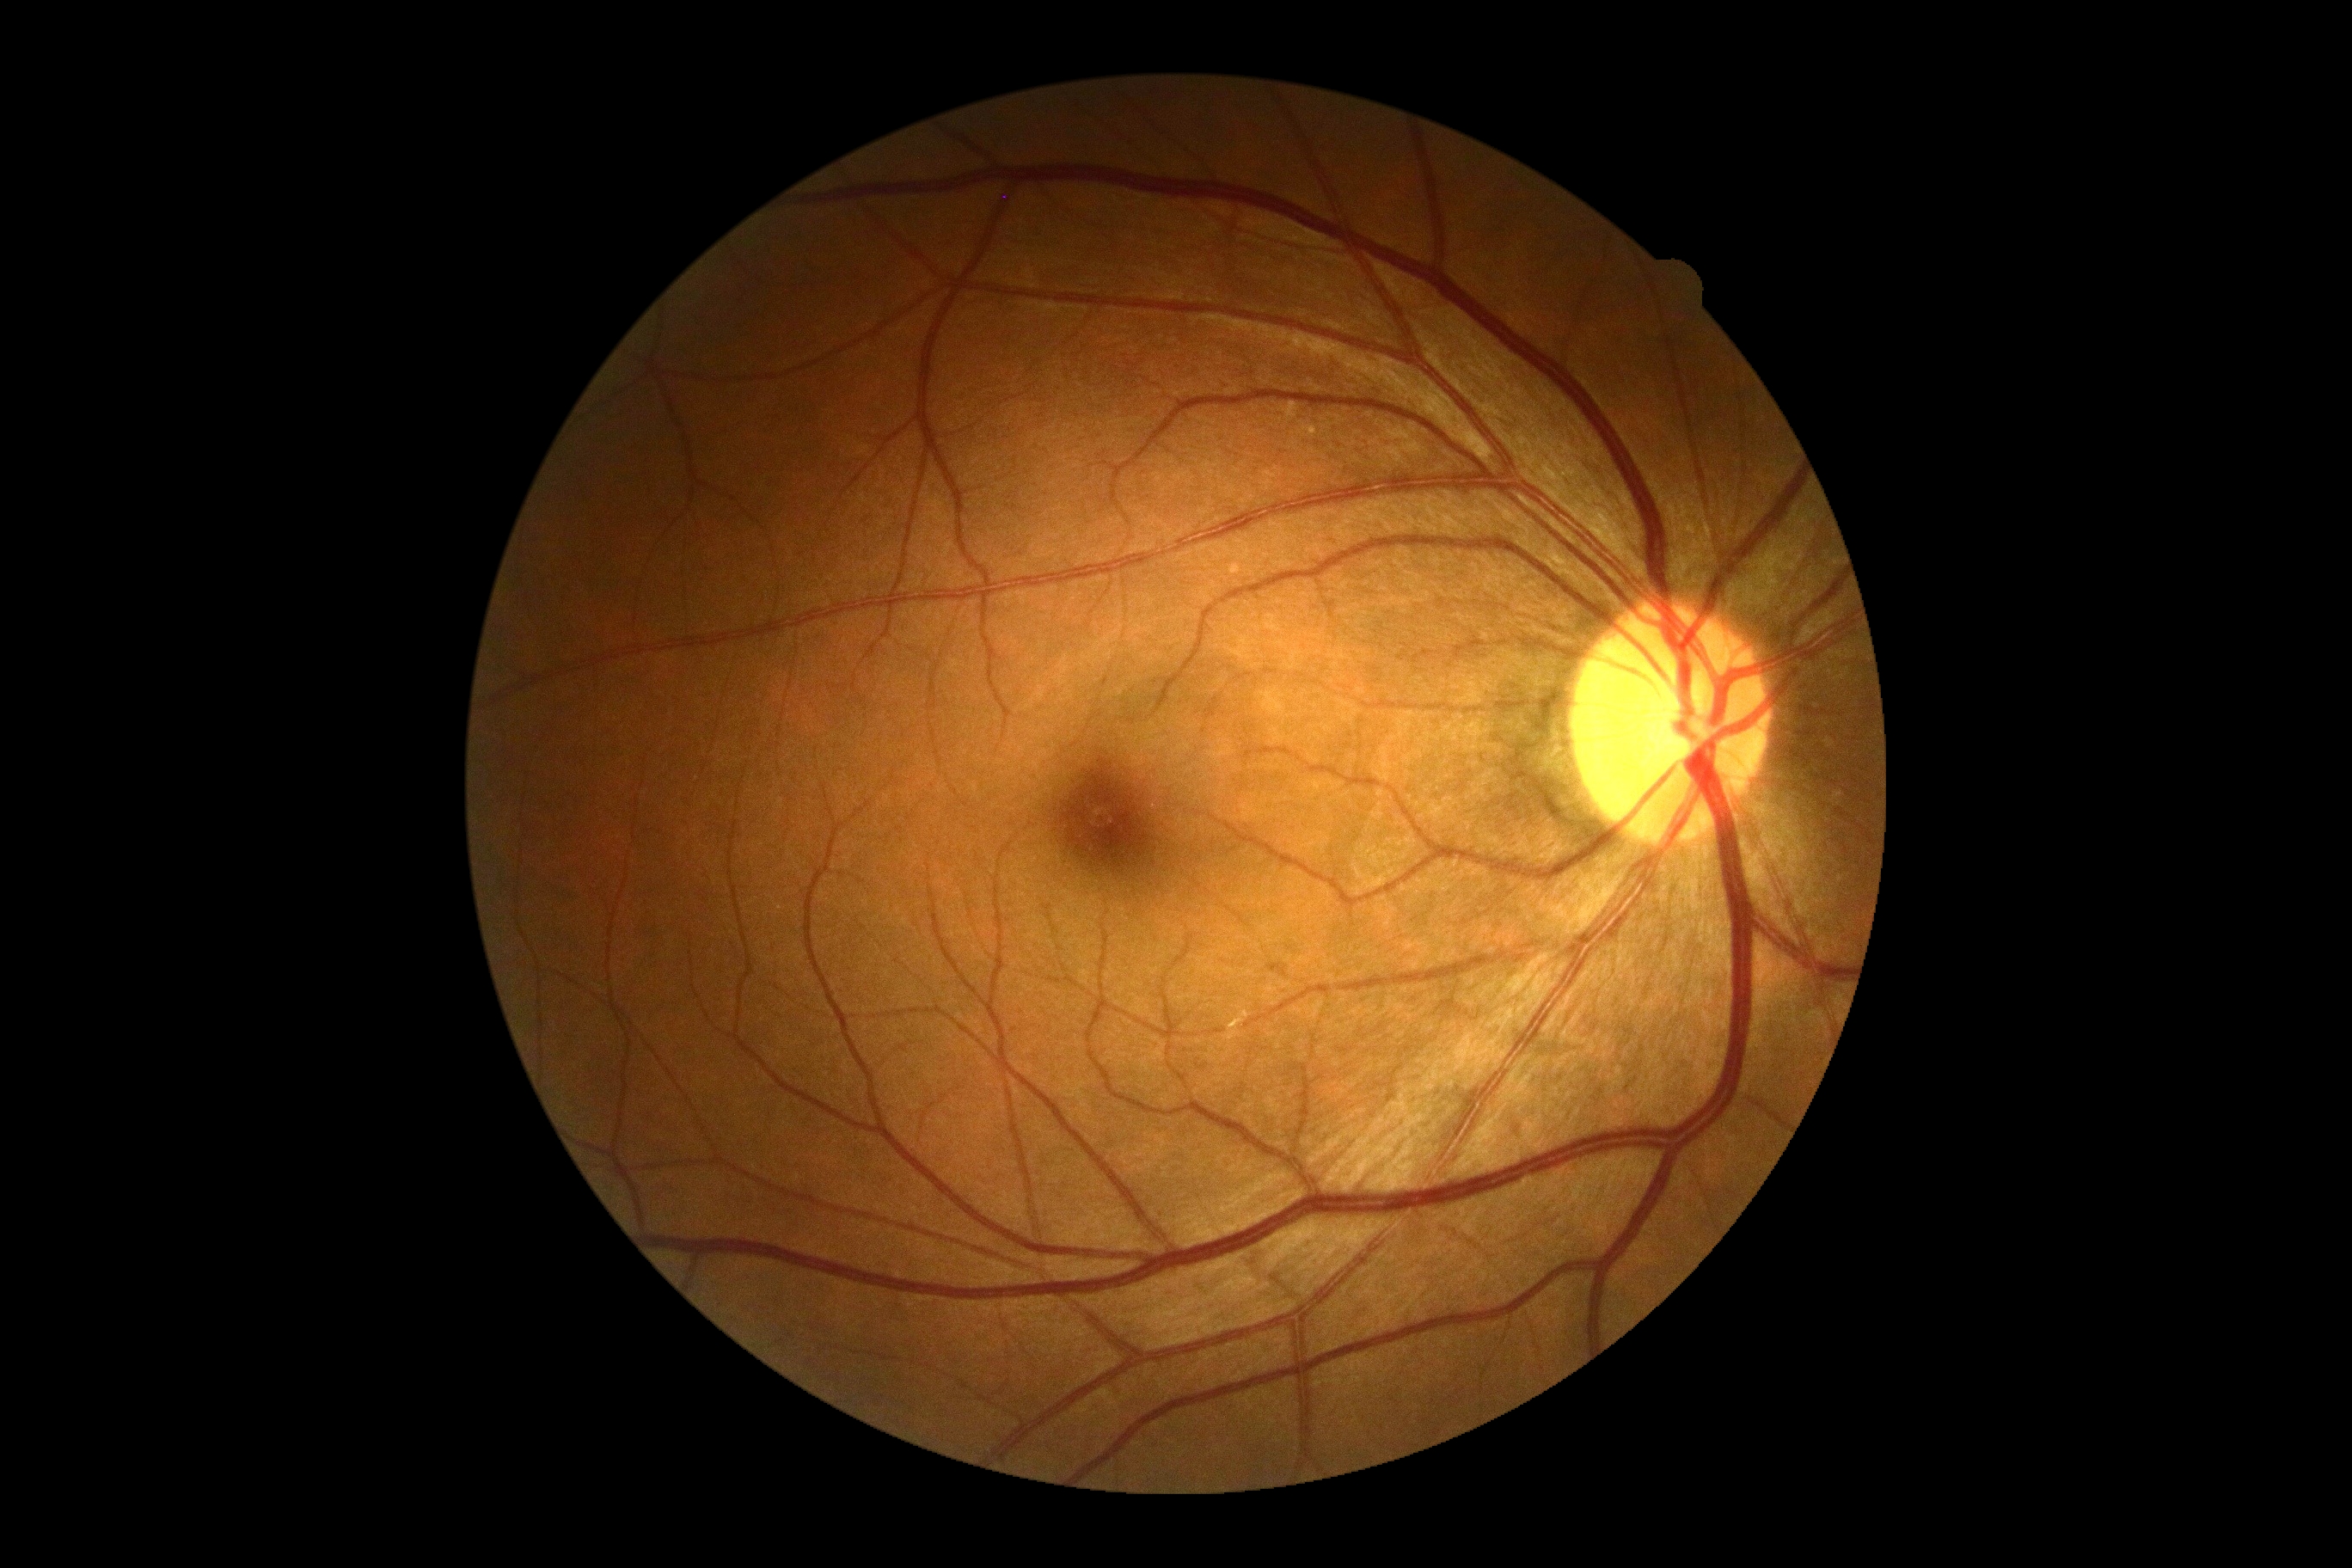
{"dr_grade": "grade 0 (no apparent retinopathy)"}